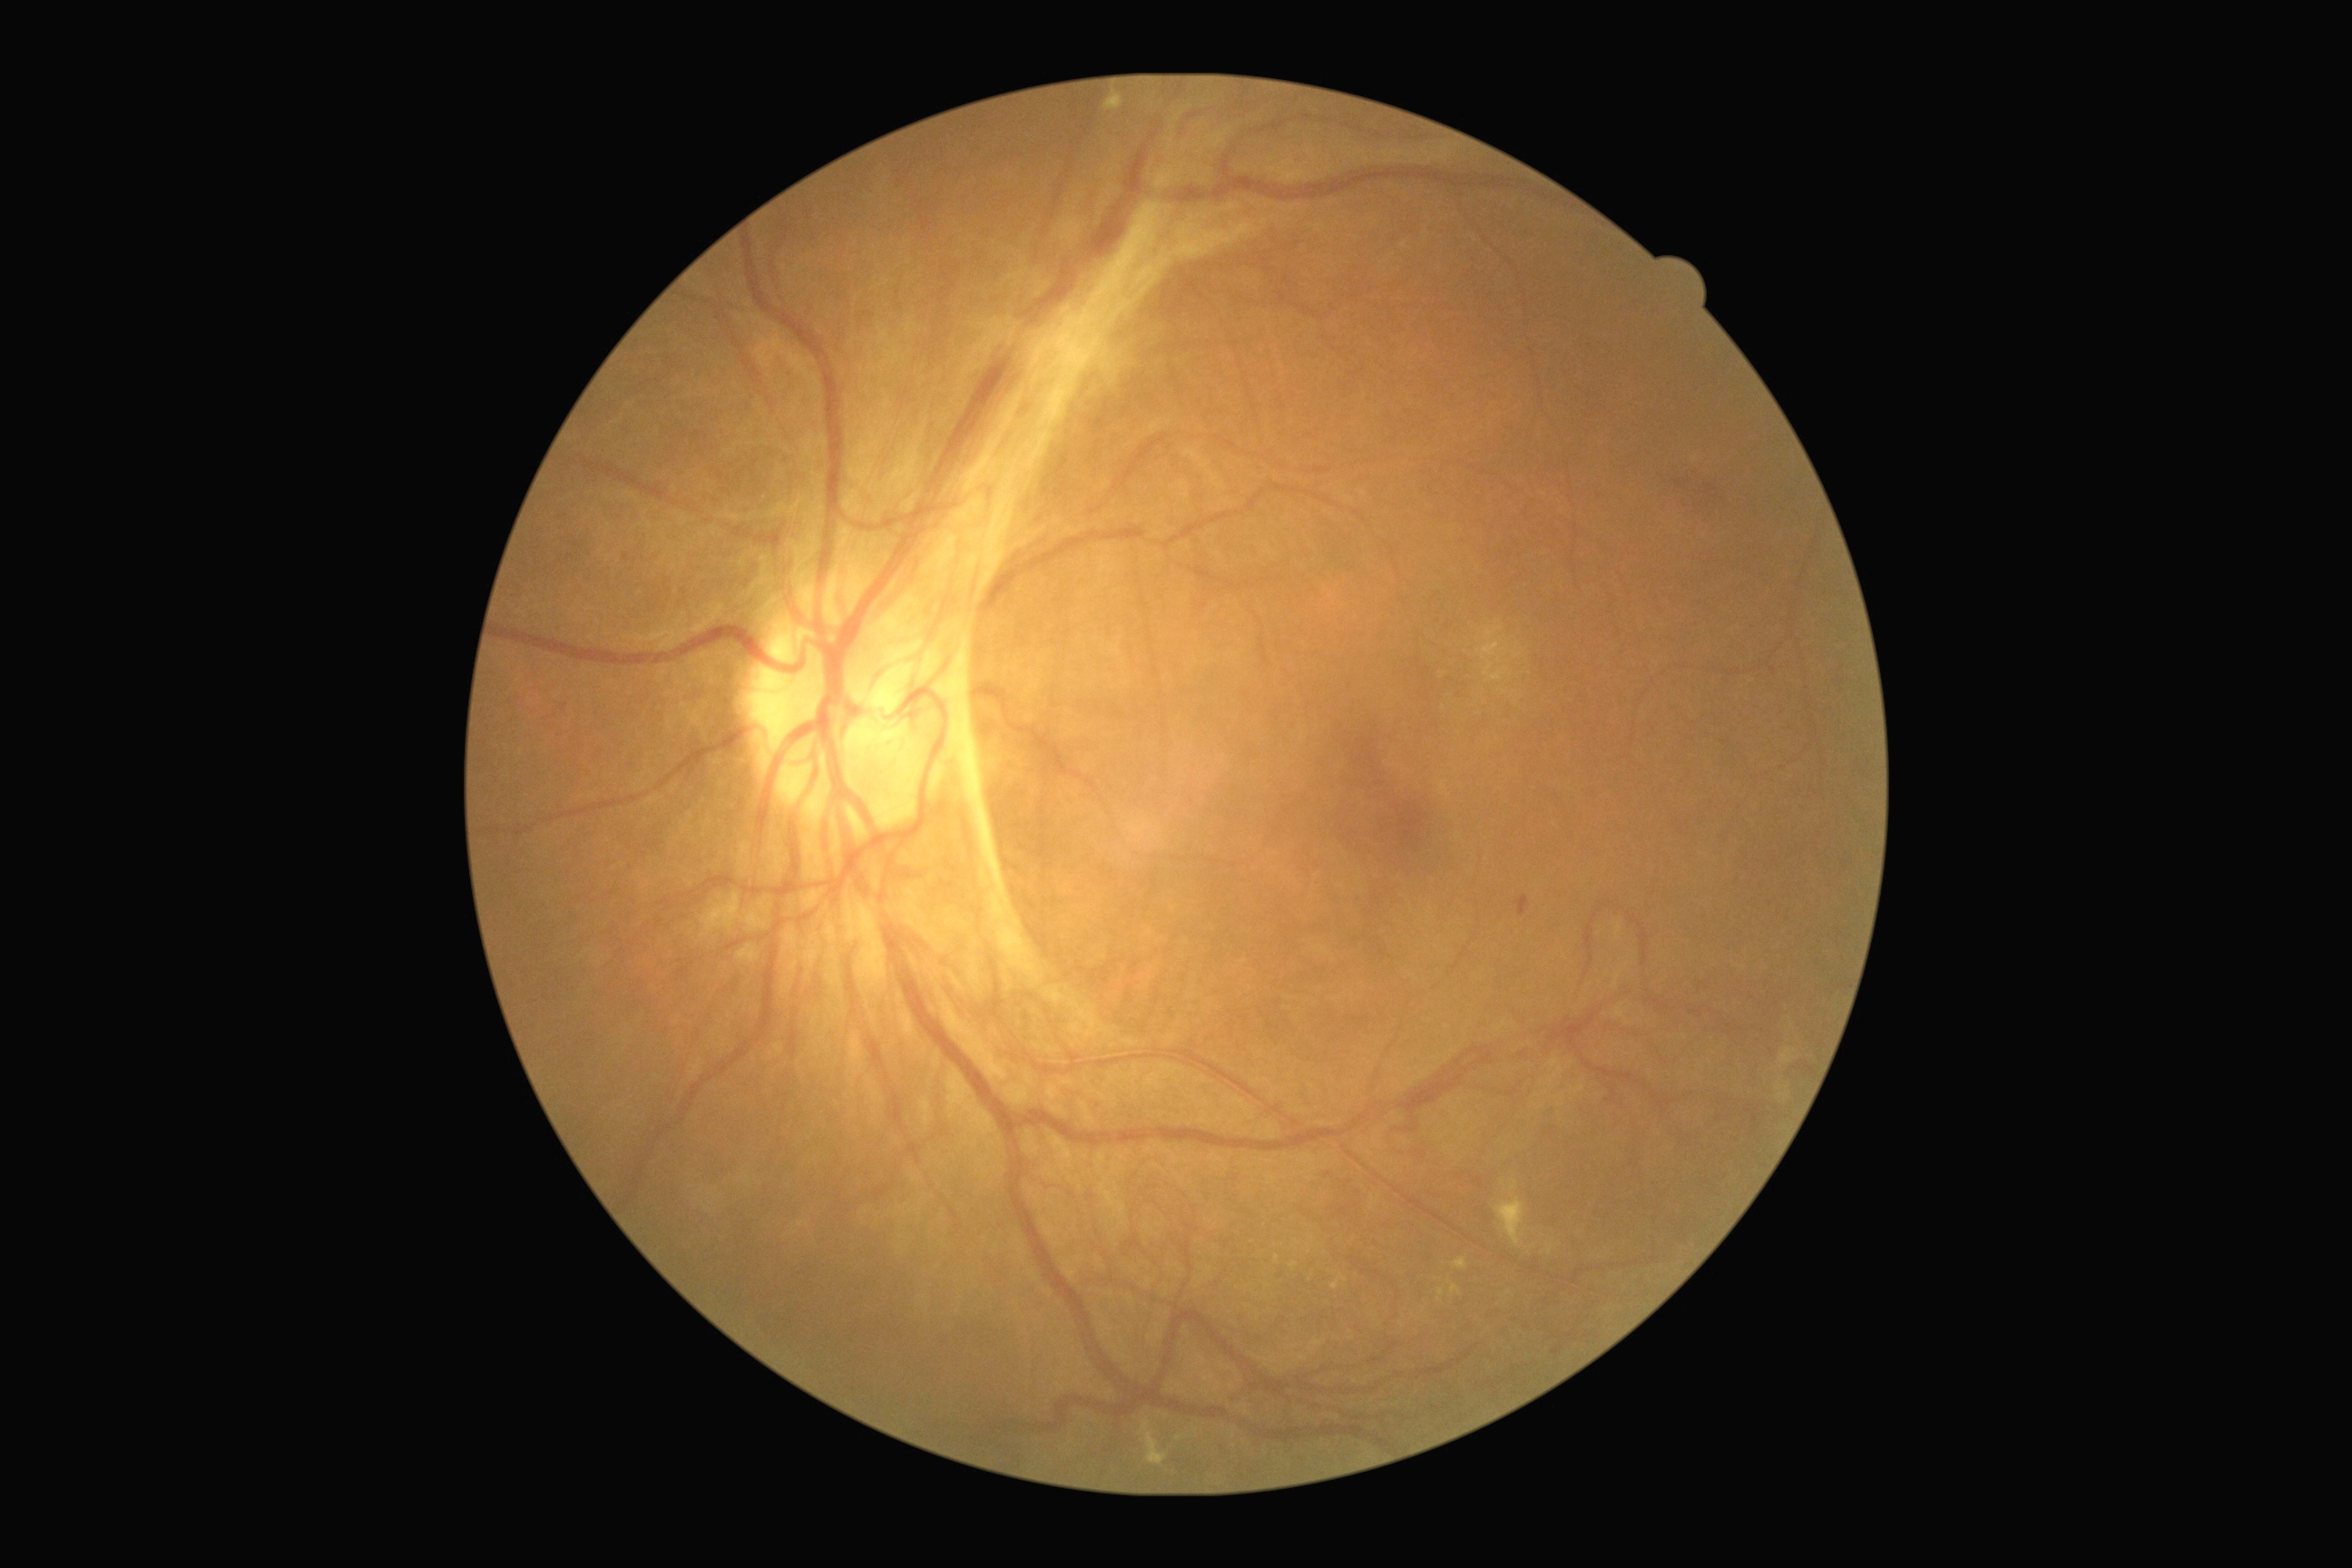 DR stage is 4/4.